Infant wide-field fundus photograph; 1440 by 1080 pixels; acquired on the Natus RetCam Envision
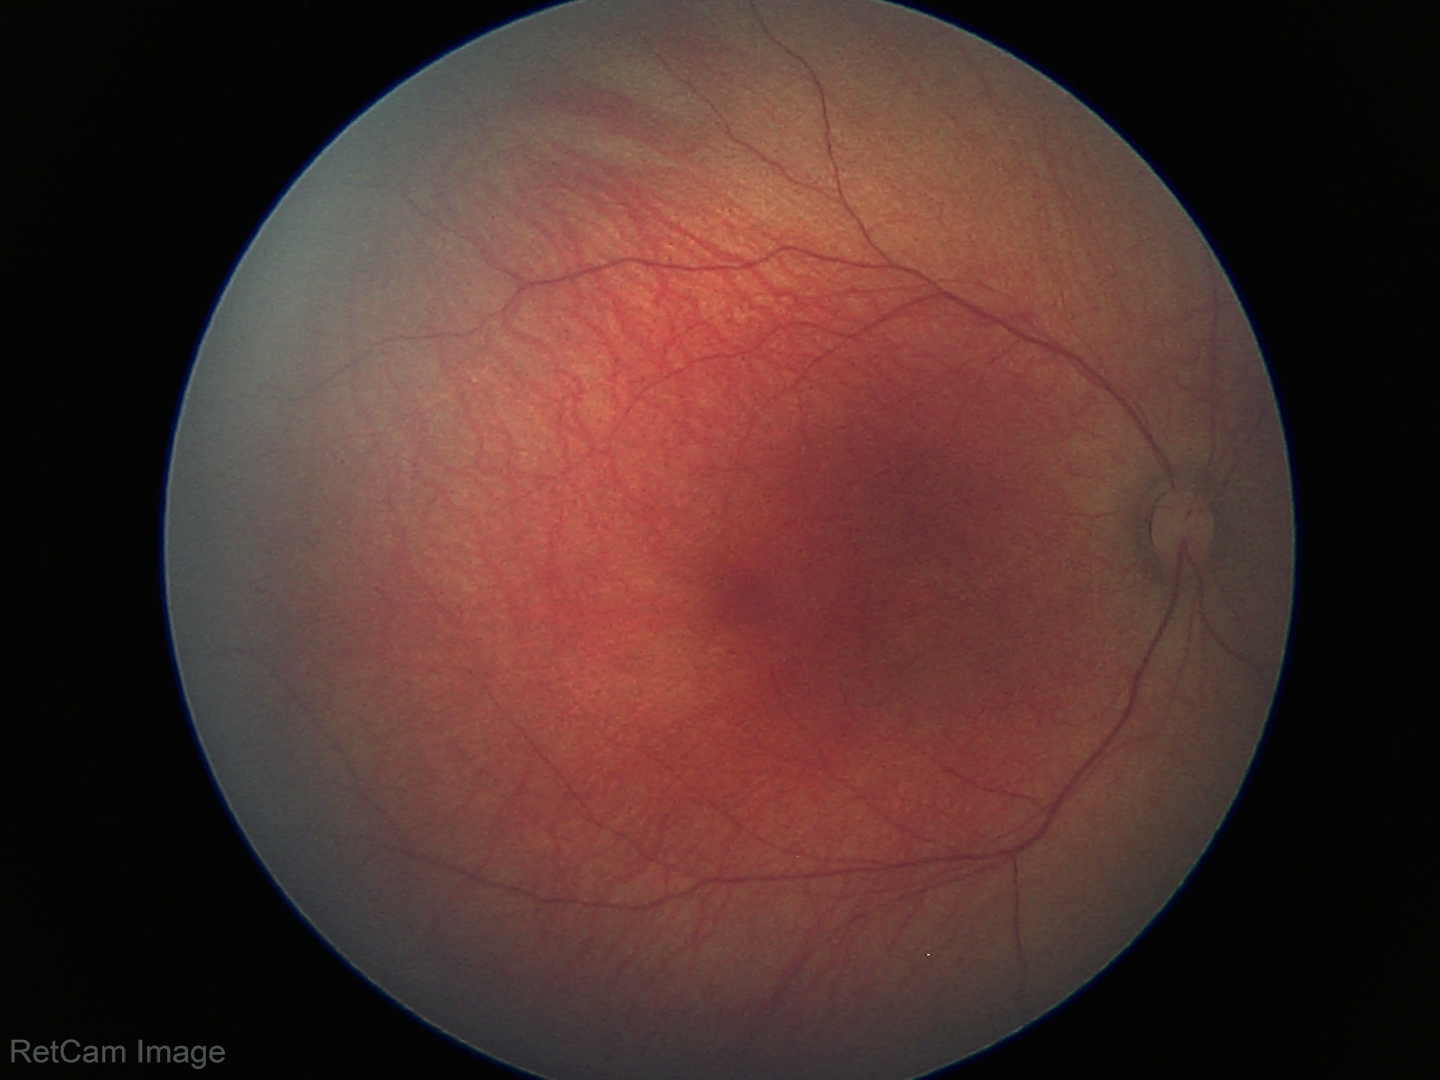 No retinal pathology identified on screening.